45° FOV: 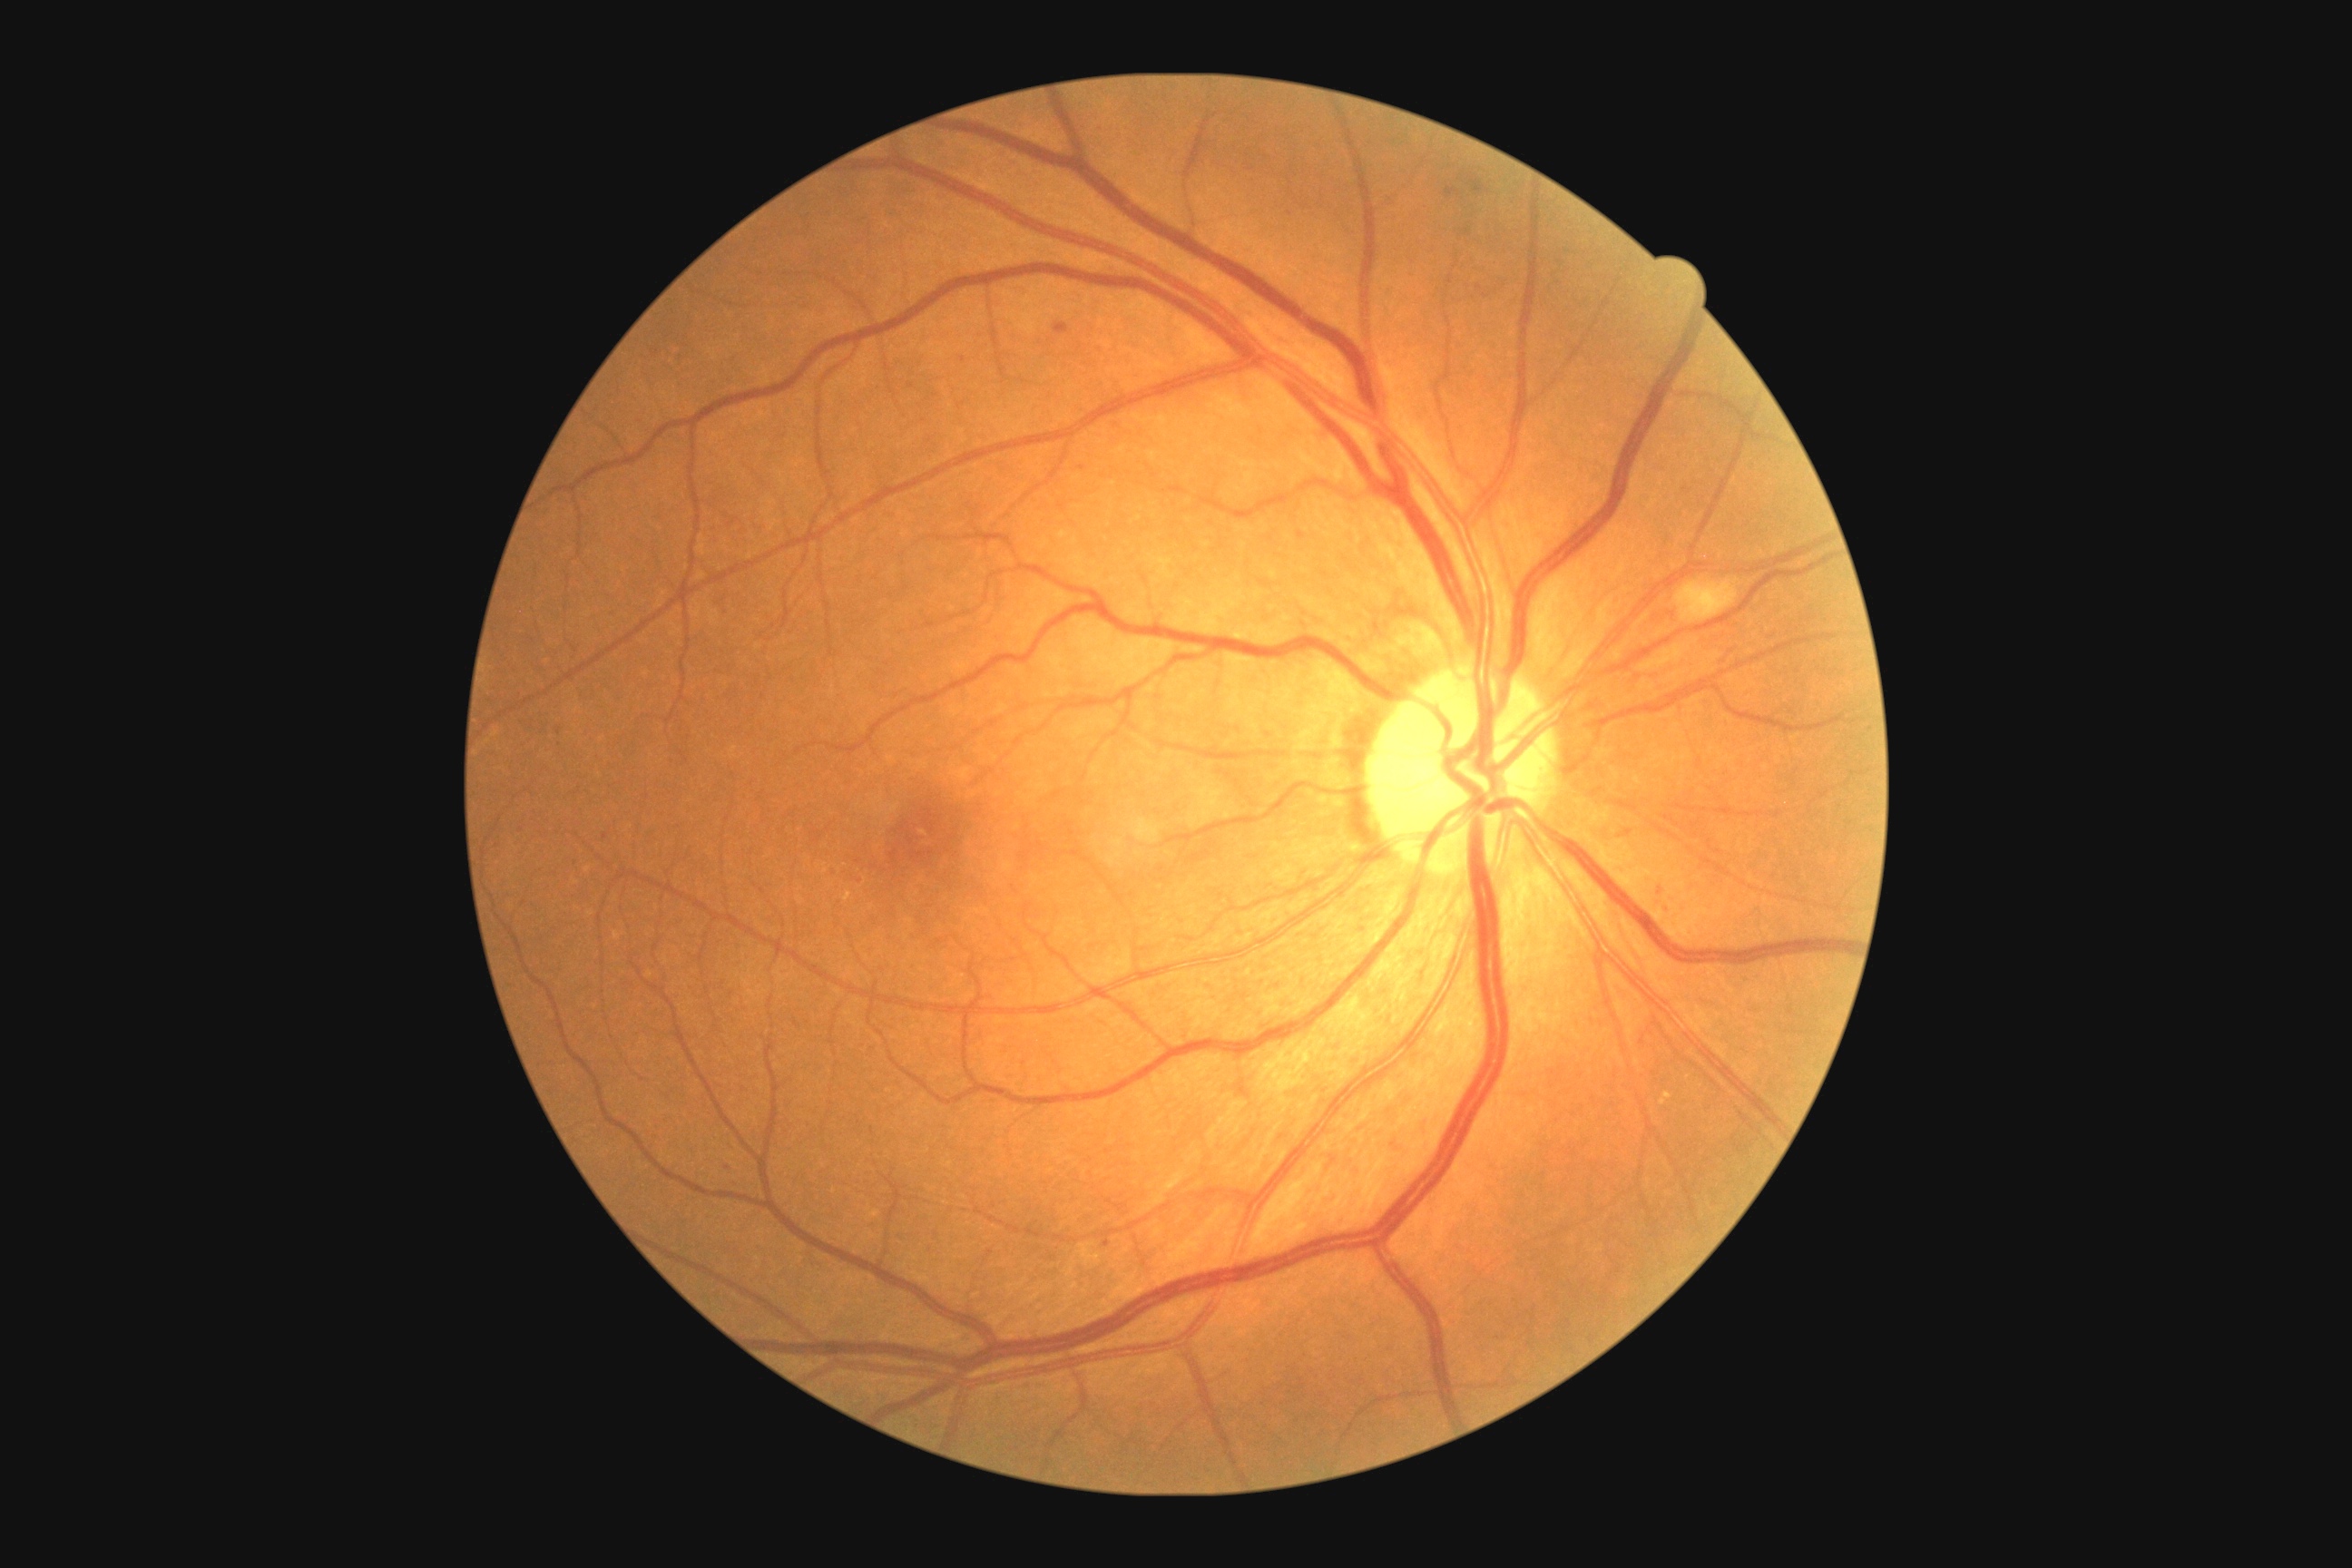 {"partial":true,"dr_grade":2,"dr_grade_name":"moderate NPDR","lesions":{"he":null,"se":[[1676,580,1740,623]],"ex":null,"ma":[[1665,901,1669,910],[1446,188,1460,197],[1469,177,1485,193],[1055,322,1070,335],[1104,1240,1110,1248],[1297,531,1306,540],[1625,830,1632,838]],"ma_small_approx":[[861,881],[963,360],[559,732],[1661,890],[1083,468],[858,862],[606,836],[727,1168]]}}